Color fundus photograph
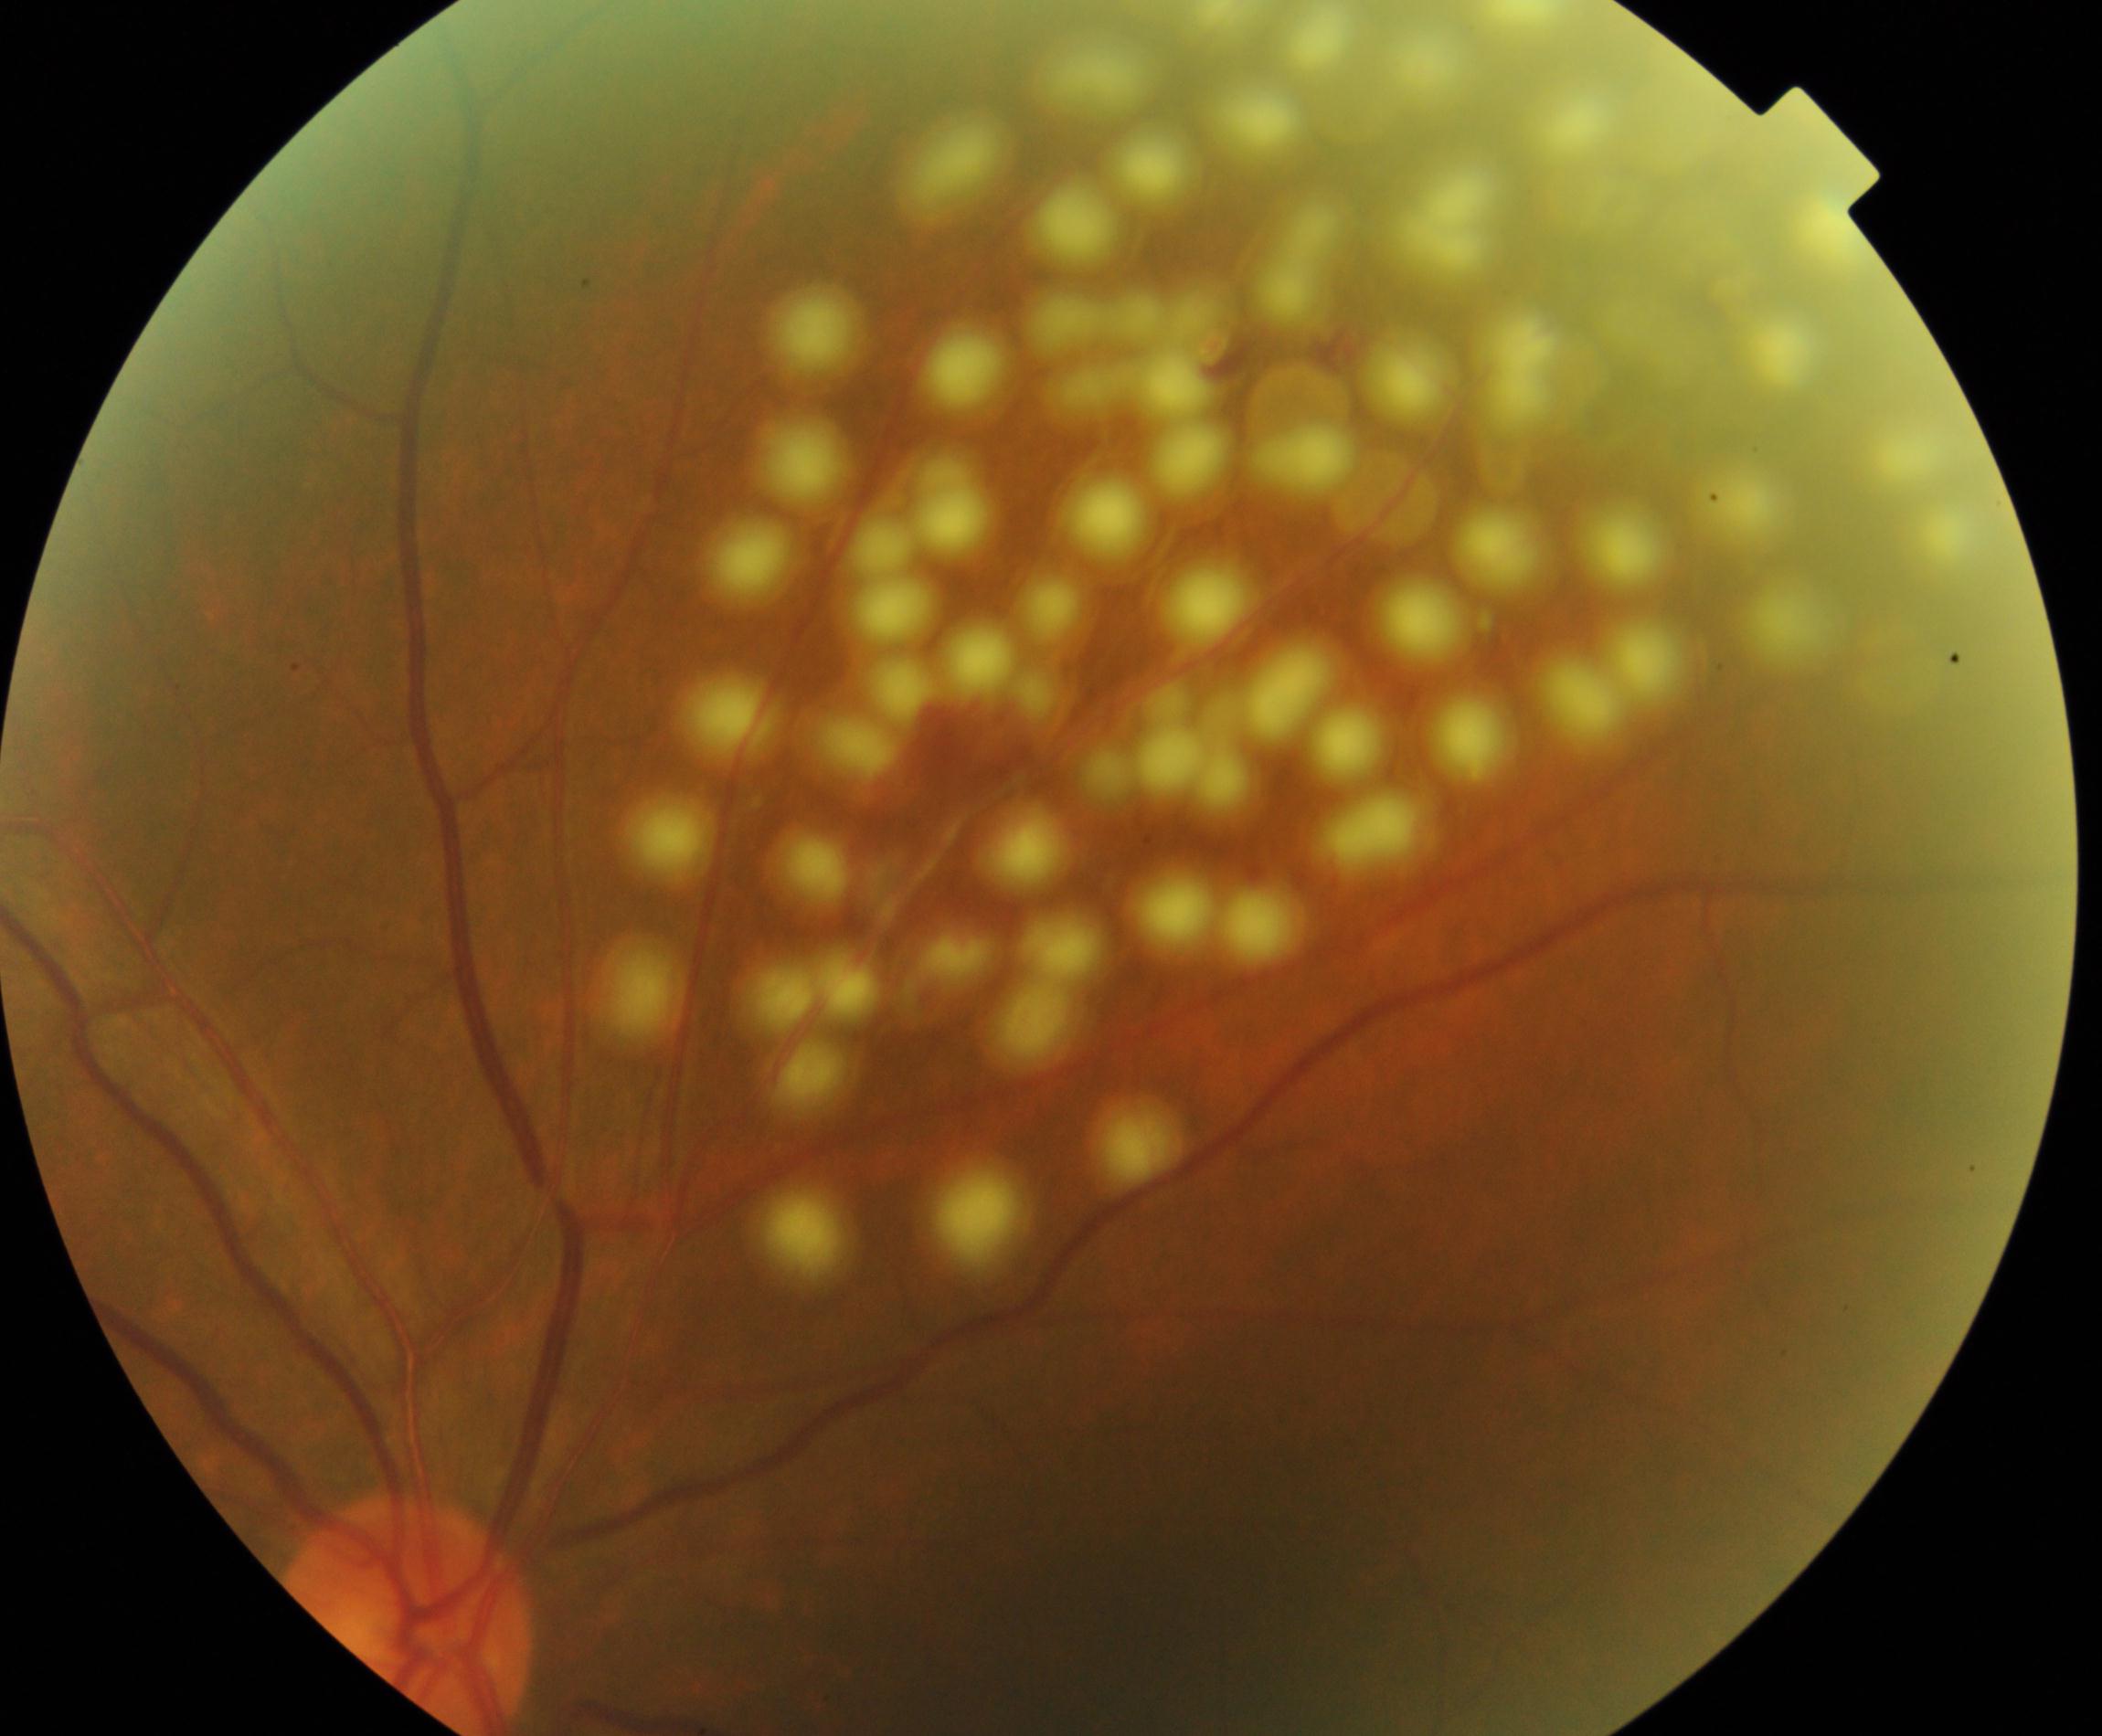
Laser spots, consistent with prior treatment.